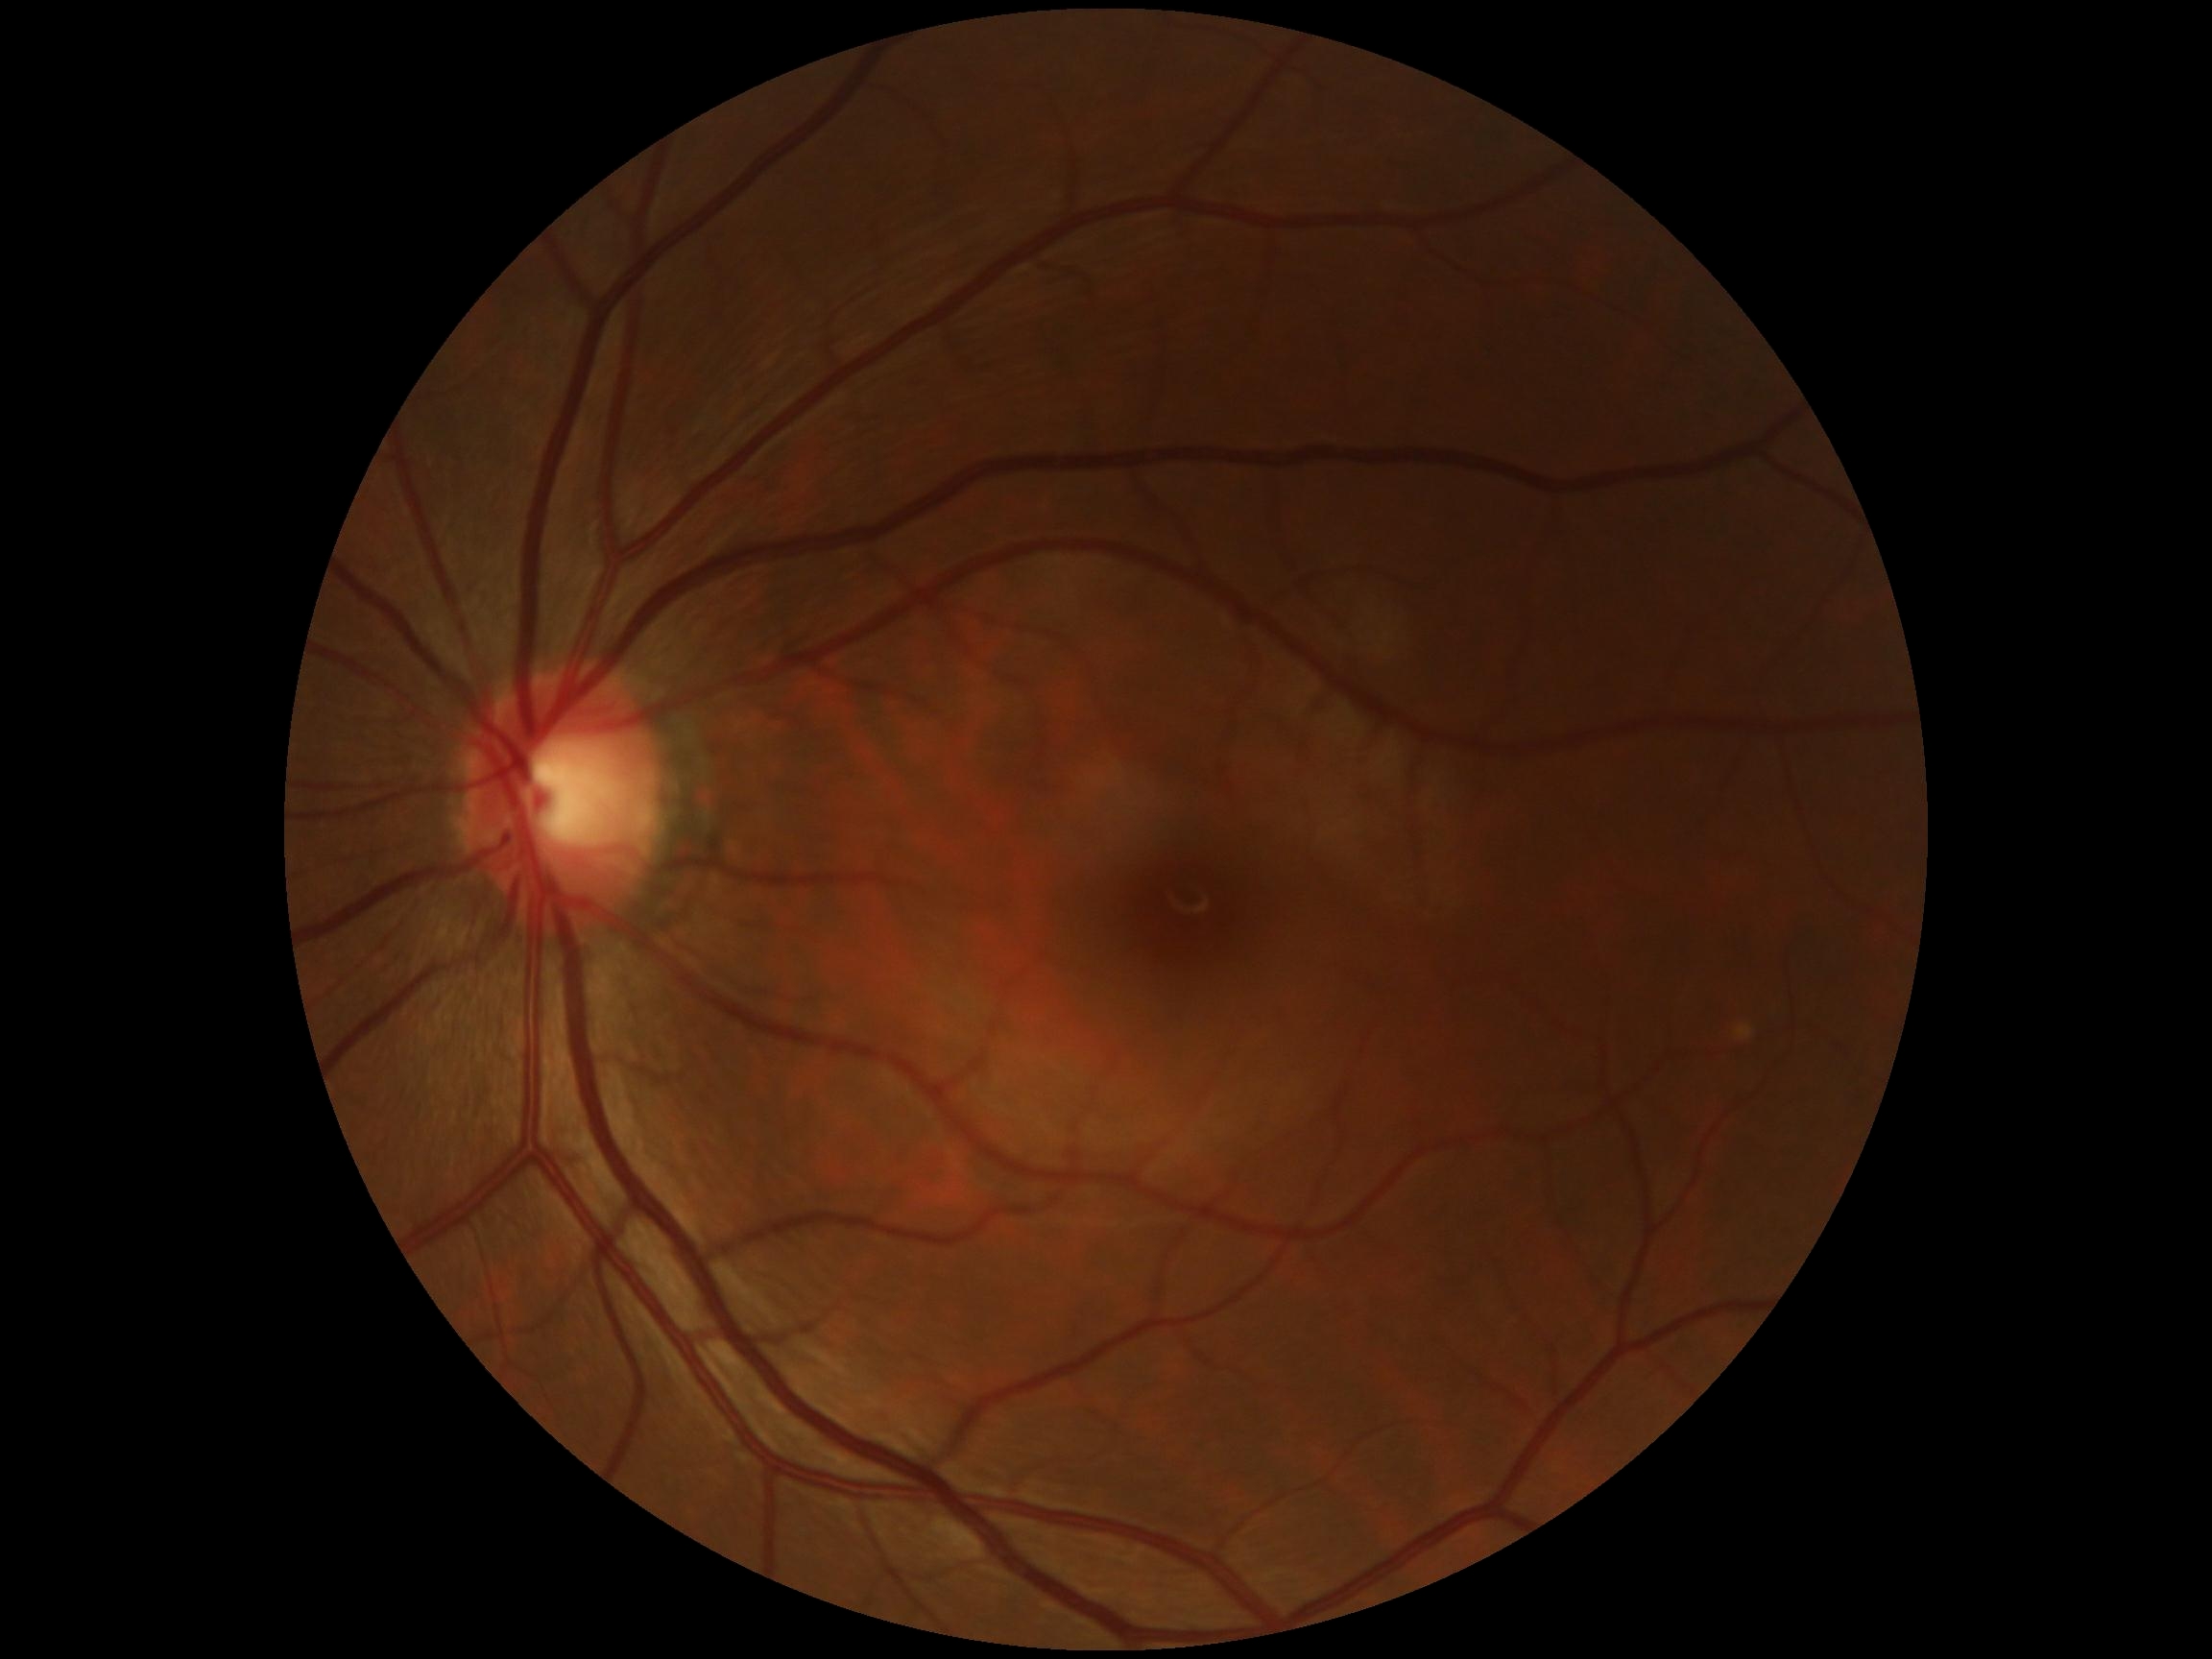 Diabetic retinopathy (DR) is 0/4. No DR findings.